Optic disc region crop — 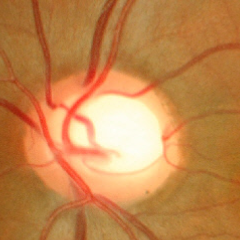
Fundus image with findings of no glaucomatous optic neuropathy.